45-degree field of view, posterior pole photograph:
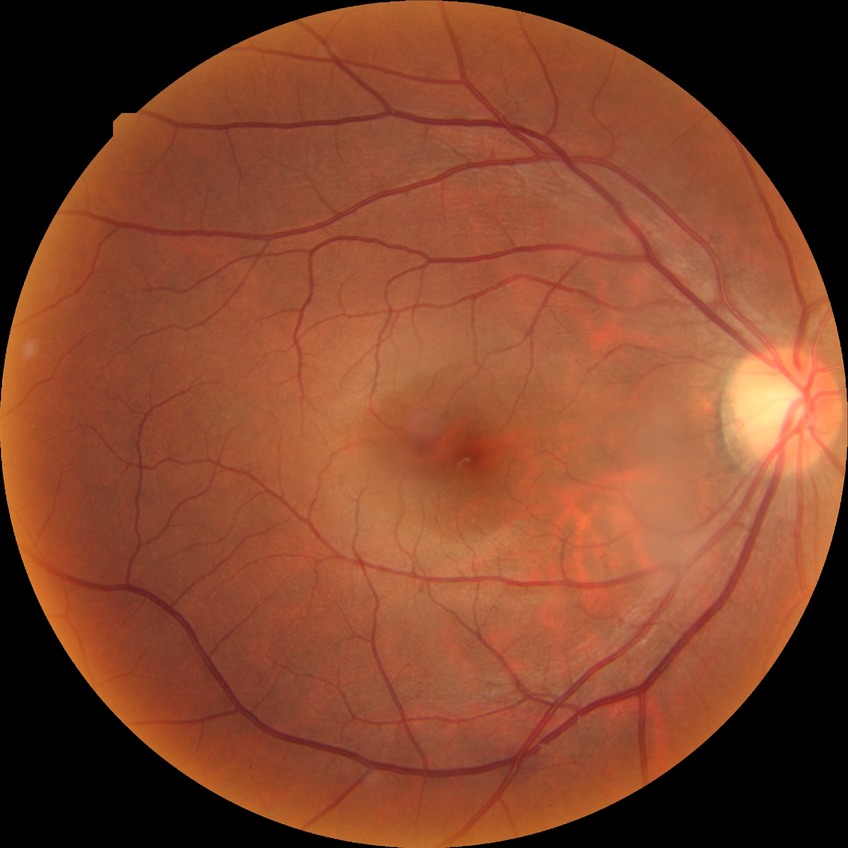

diabetic retinopathy (DR): no diabetic retinopathy (NDR).